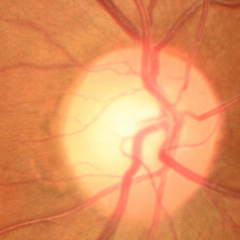 No glaucoma.